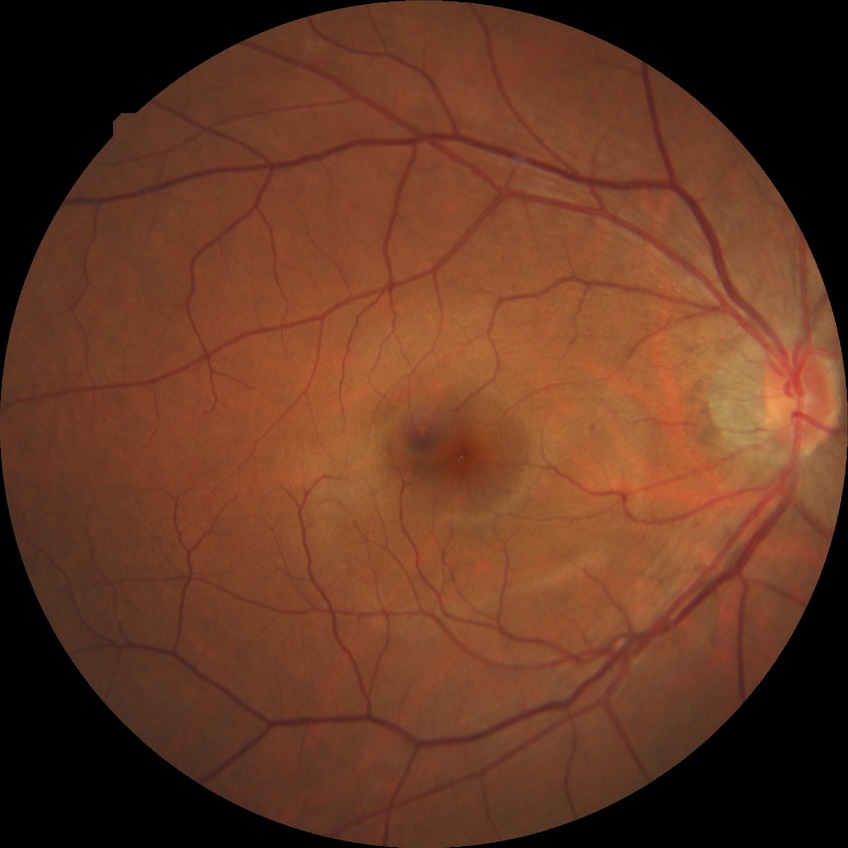 diabetic retinopathy stage = no diabetic retinopathy.